CFP. Nonmydriatic fundus photograph.
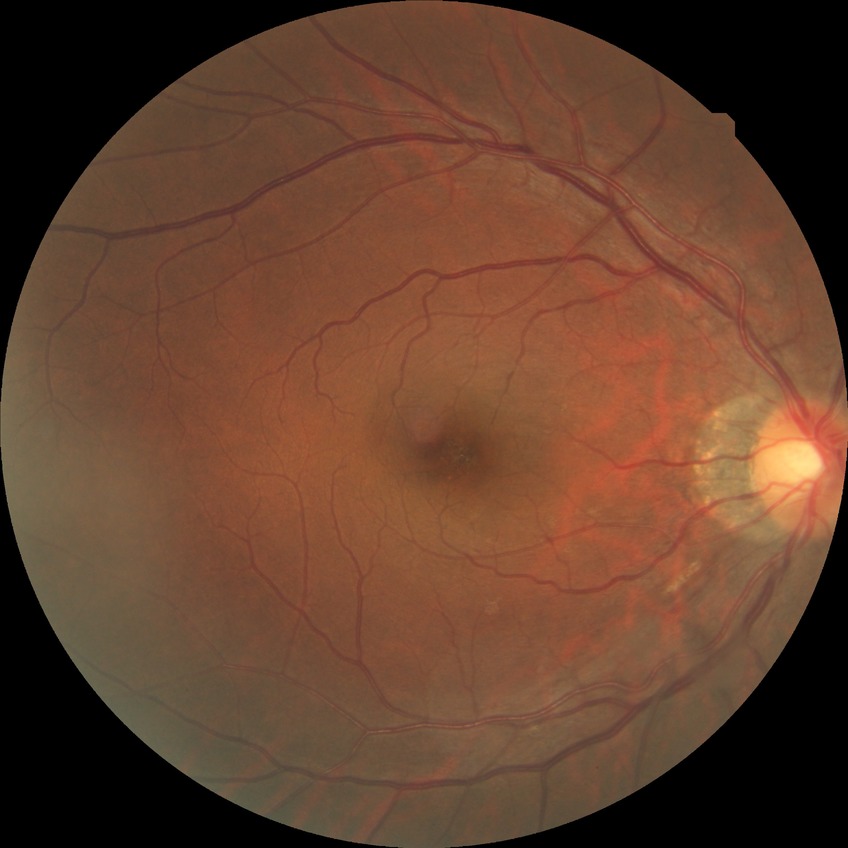

Assessment:
• diabetic retinopathy severity — no diabetic retinopathy